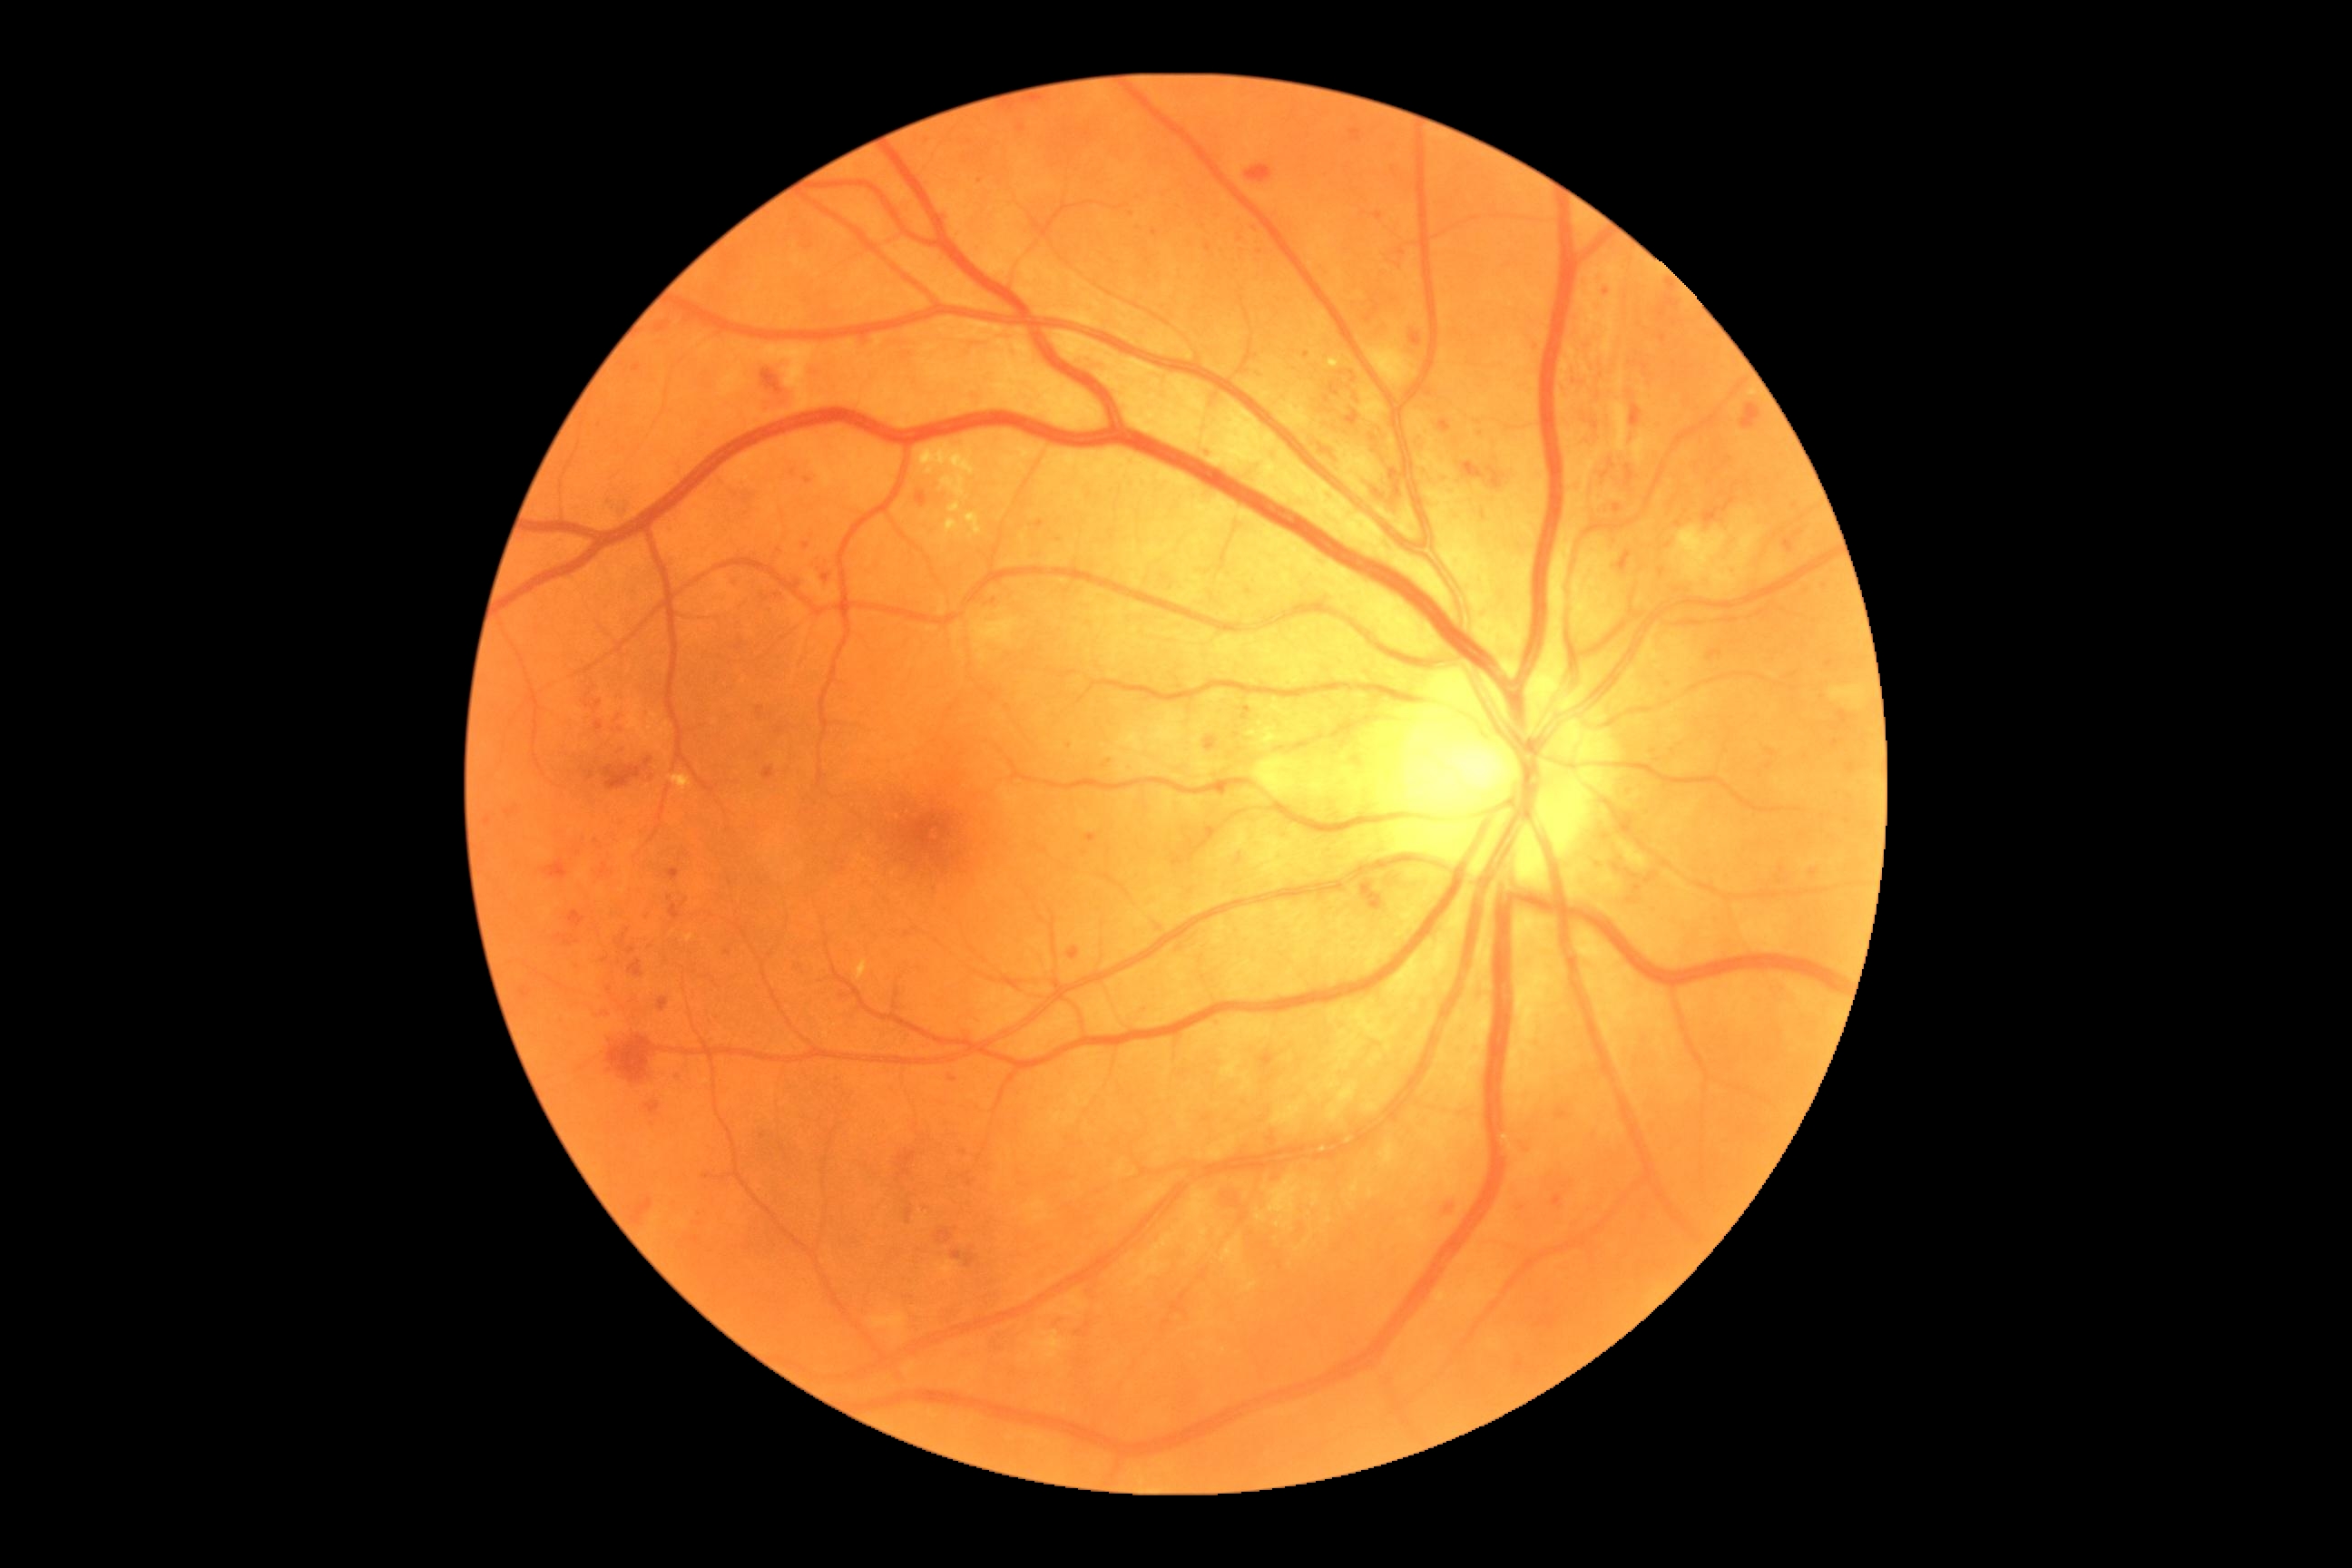

Diabetic retinopathy (DR) is grade 3; non-proliferative diabetic retinopathy
Lesions identified (partial list):
hemorrhages (HEs) (more not shown) = 614,747,627,756 | 1462,462,1485,480 | 992,1333,1006,1353 | 1551,1195,1563,1208 | 897,1150,916,1179 | 1204,736,1217,752 | 658,999,669,1012 | 616,934,627,945 | 743,495,758,511 | 645,758,652,769 | 556,936,573,946 | 1219,1188,1246,1211 | 916,493,928,507 | 1785,540,1794,553 | 1614,504,1623,513 | 1411,333,1422,346 | 1707,651,1723,662 | 761,369,792,411 | 948,1075,957,1083
Additional small HEs near 1662:571
microaneurysms (MAs) (more not shown) = 1219,789,1226,798 | 1206,828,1213,836 | 669,525,676,533 | 594,721,603,730
Additional small MAs near 1669:685 | 739:482 | 793:473 | 1662:338 | 1813:873 | 727:953 | 1131:215 | 1149:263 | 1260:253 | 1020:129 | 1307:355 | 670:899 | 1209:454 | 1257:230